848x848px.
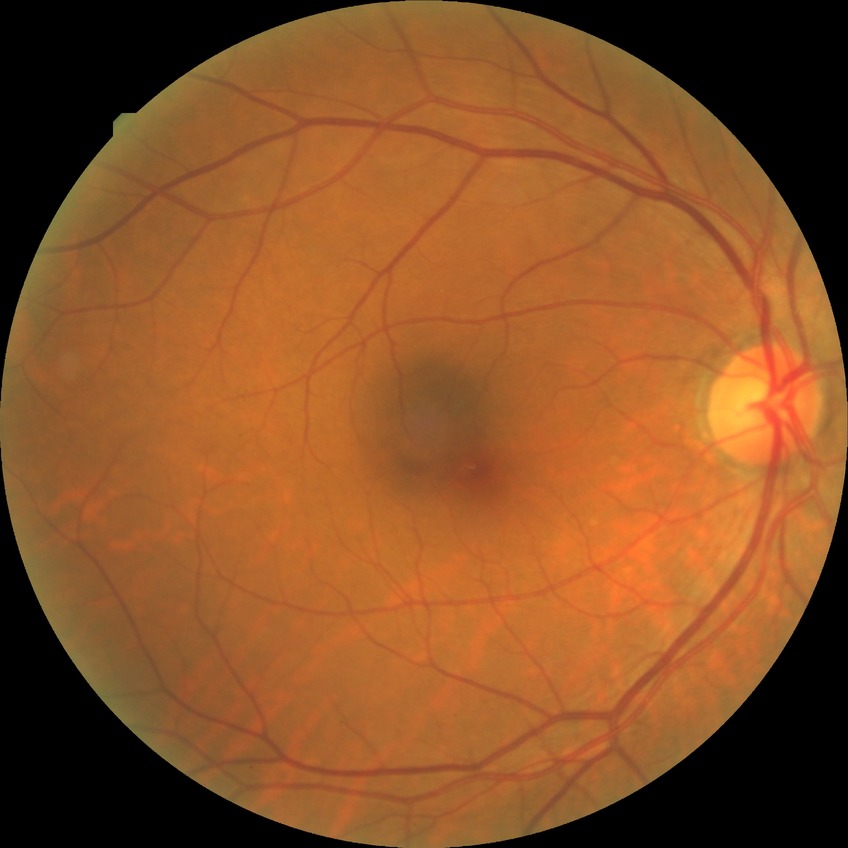
Diabetic retinopathy (DR) is no diabetic retinopathy (NDR).